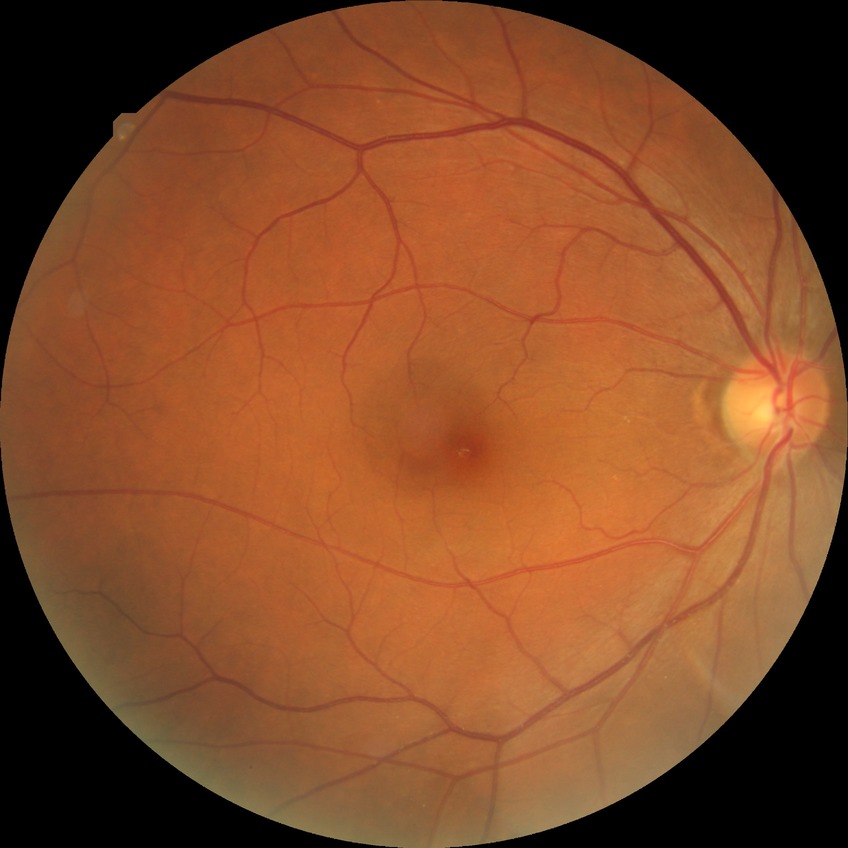
davis_grade: no diabetic retinopathy